45° field of view. 1932 by 1910 pixels — 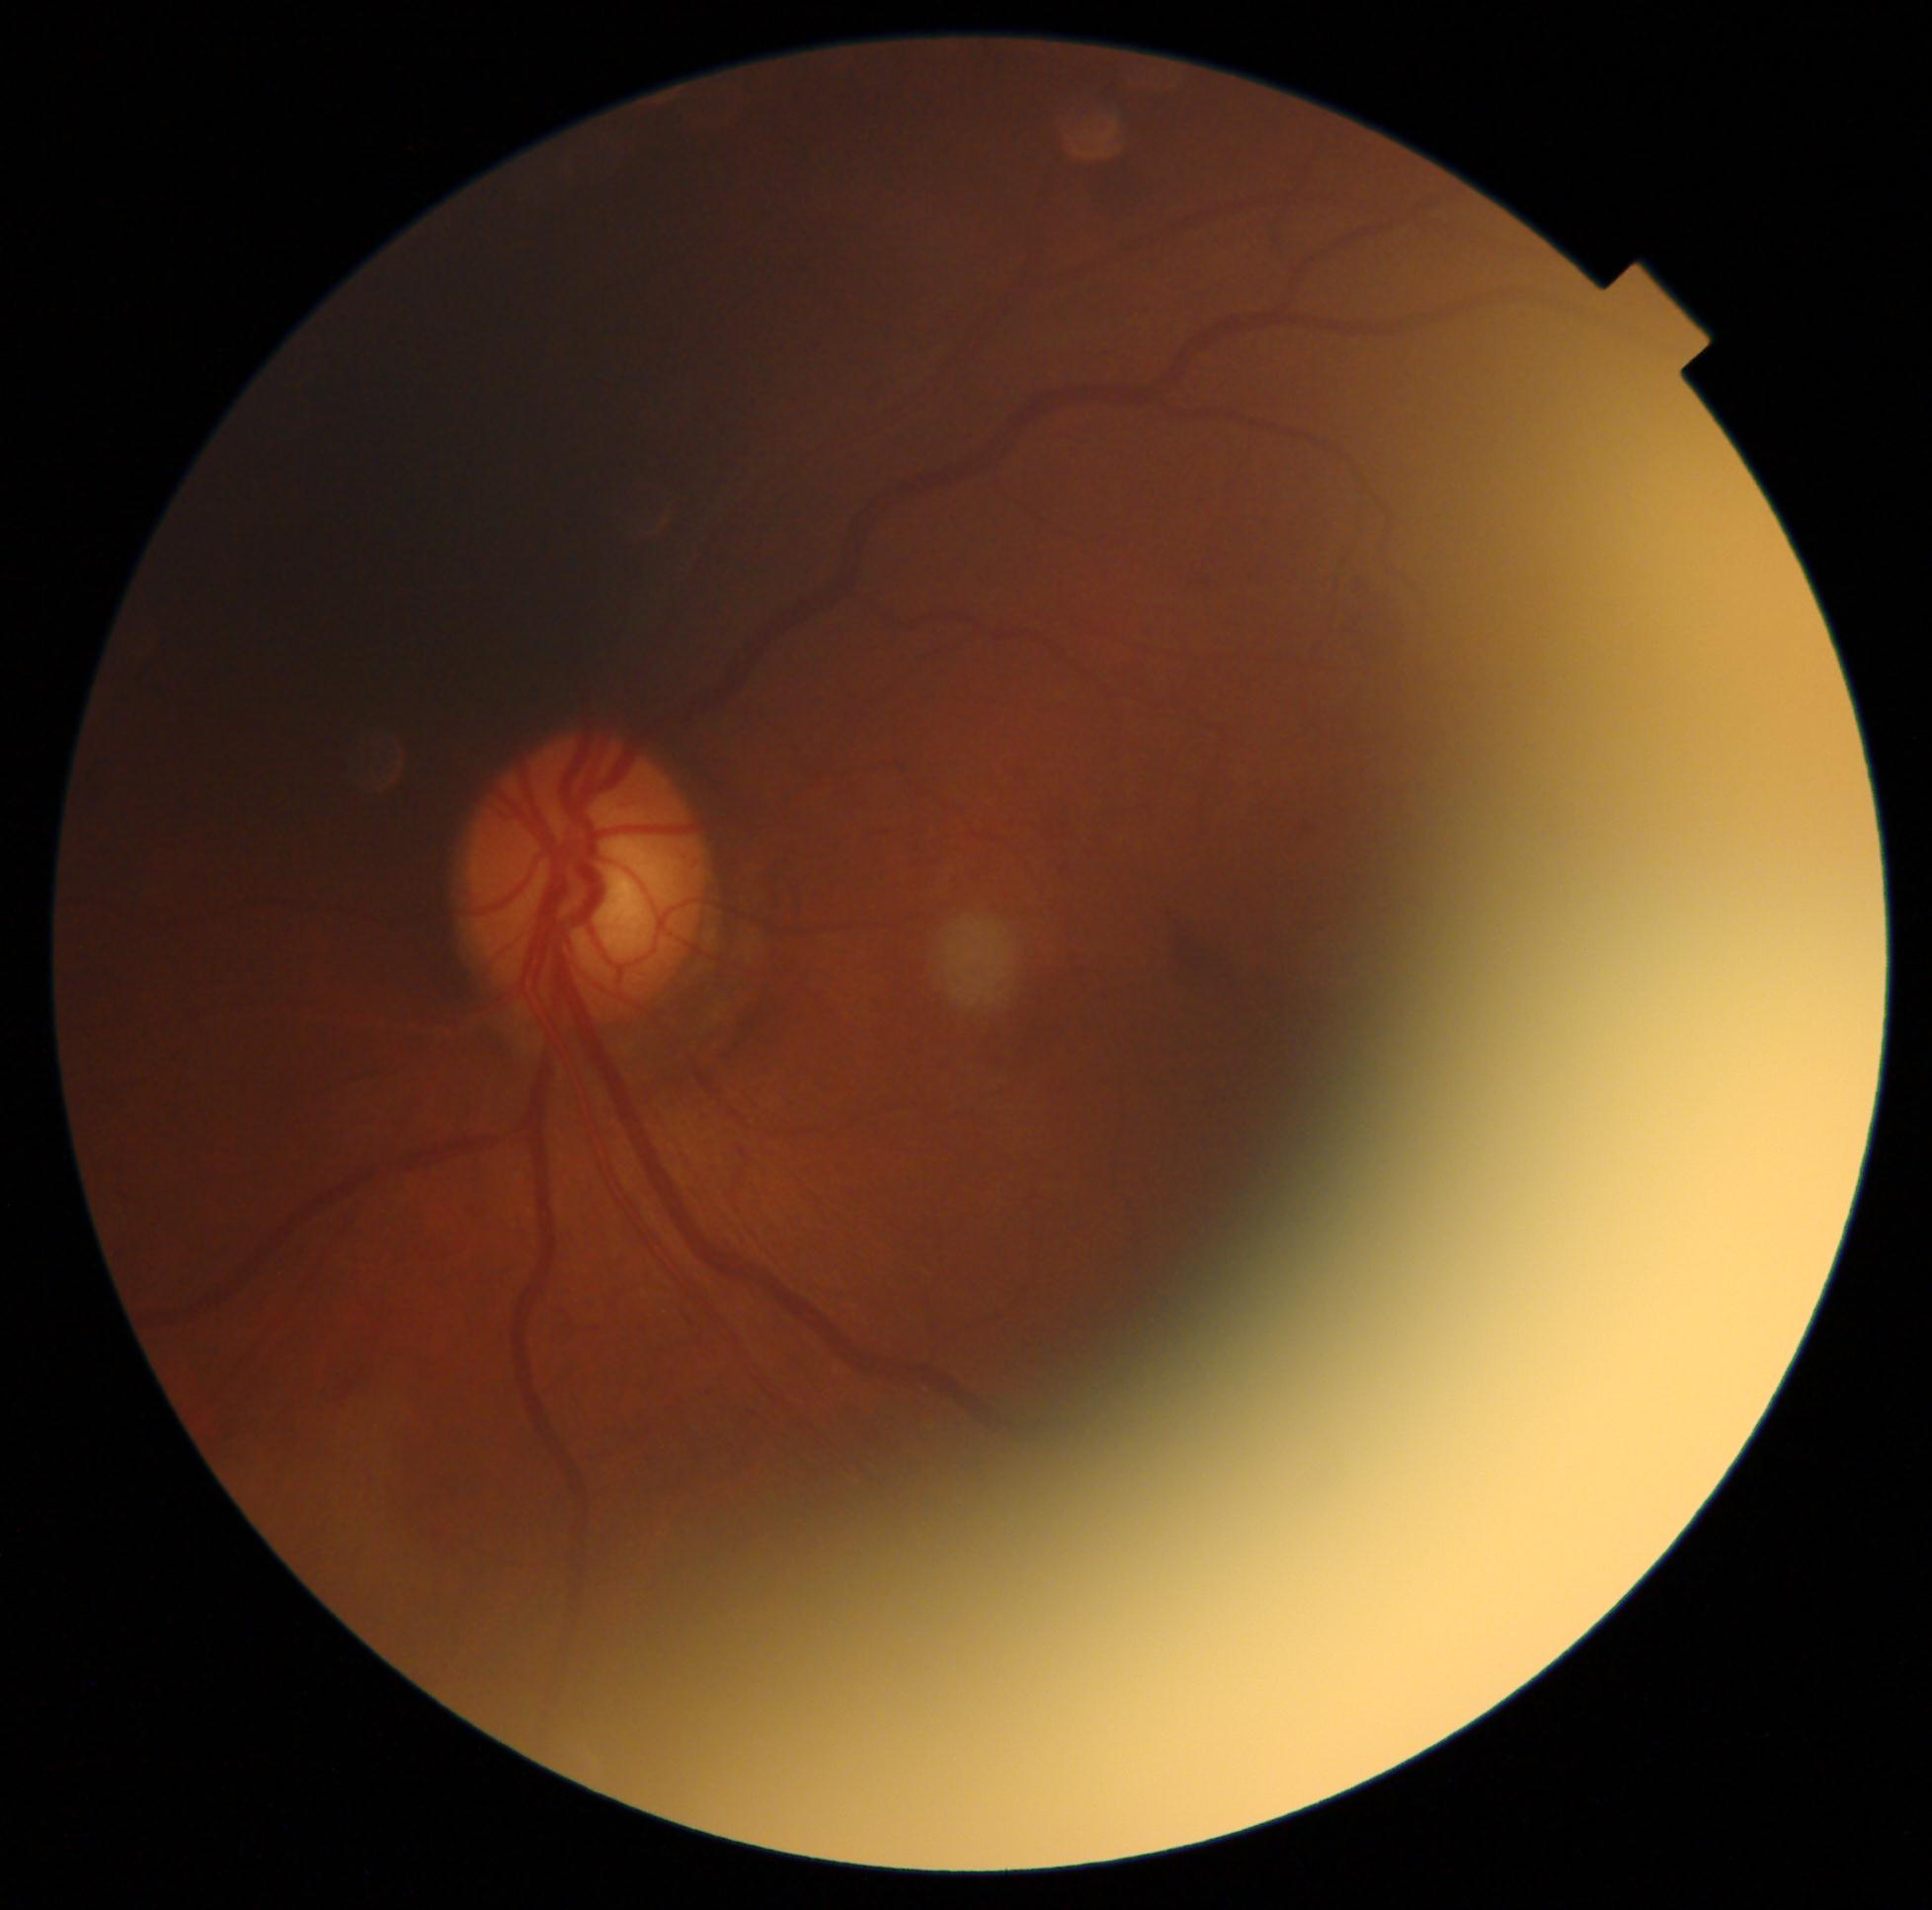

DR severity: grade 2 (moderate NPDR).